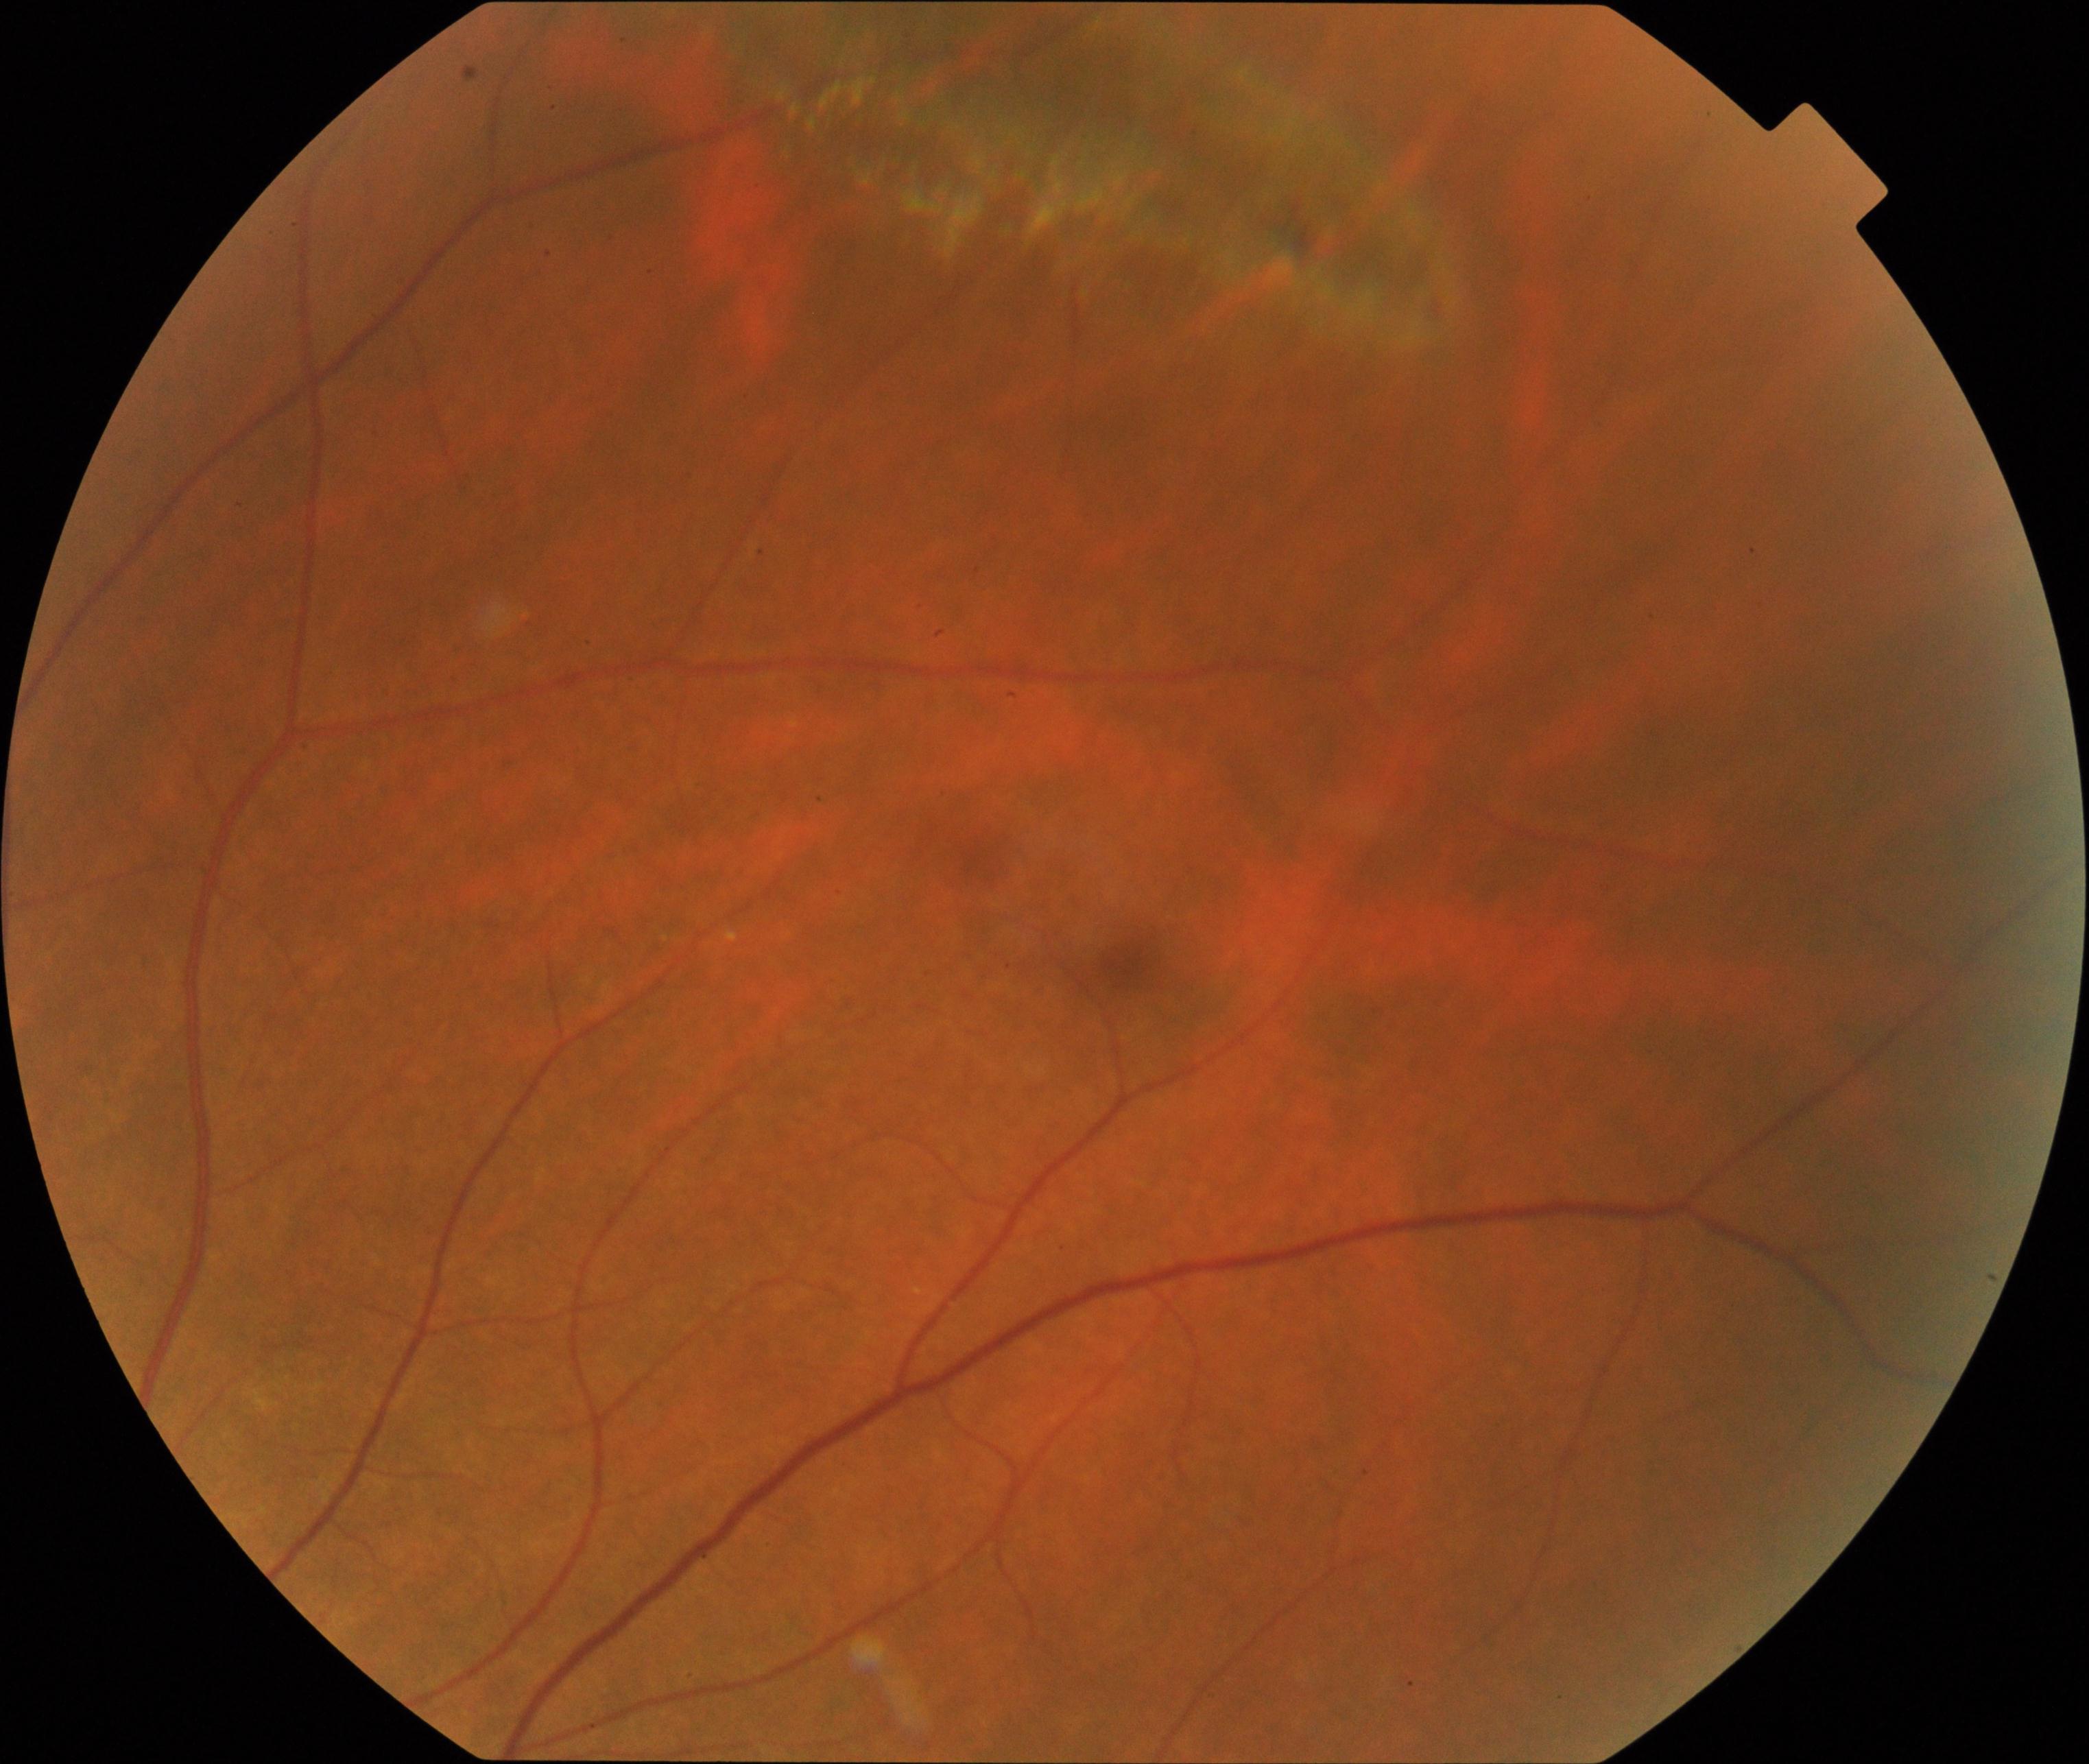
Classification: peripheral retinal degeneration and break. Defined by lattice, snailtrack, pavingstone, honeycomb, peripheral drusen, microcystoid, or white-without-pressure degeneration, sometimes with a retinal break.